Camera: Topcon TRC-50DX; color fundus photograph; mydriatic (tropicamide and phenylephrine); field includes the optic disc and macula: 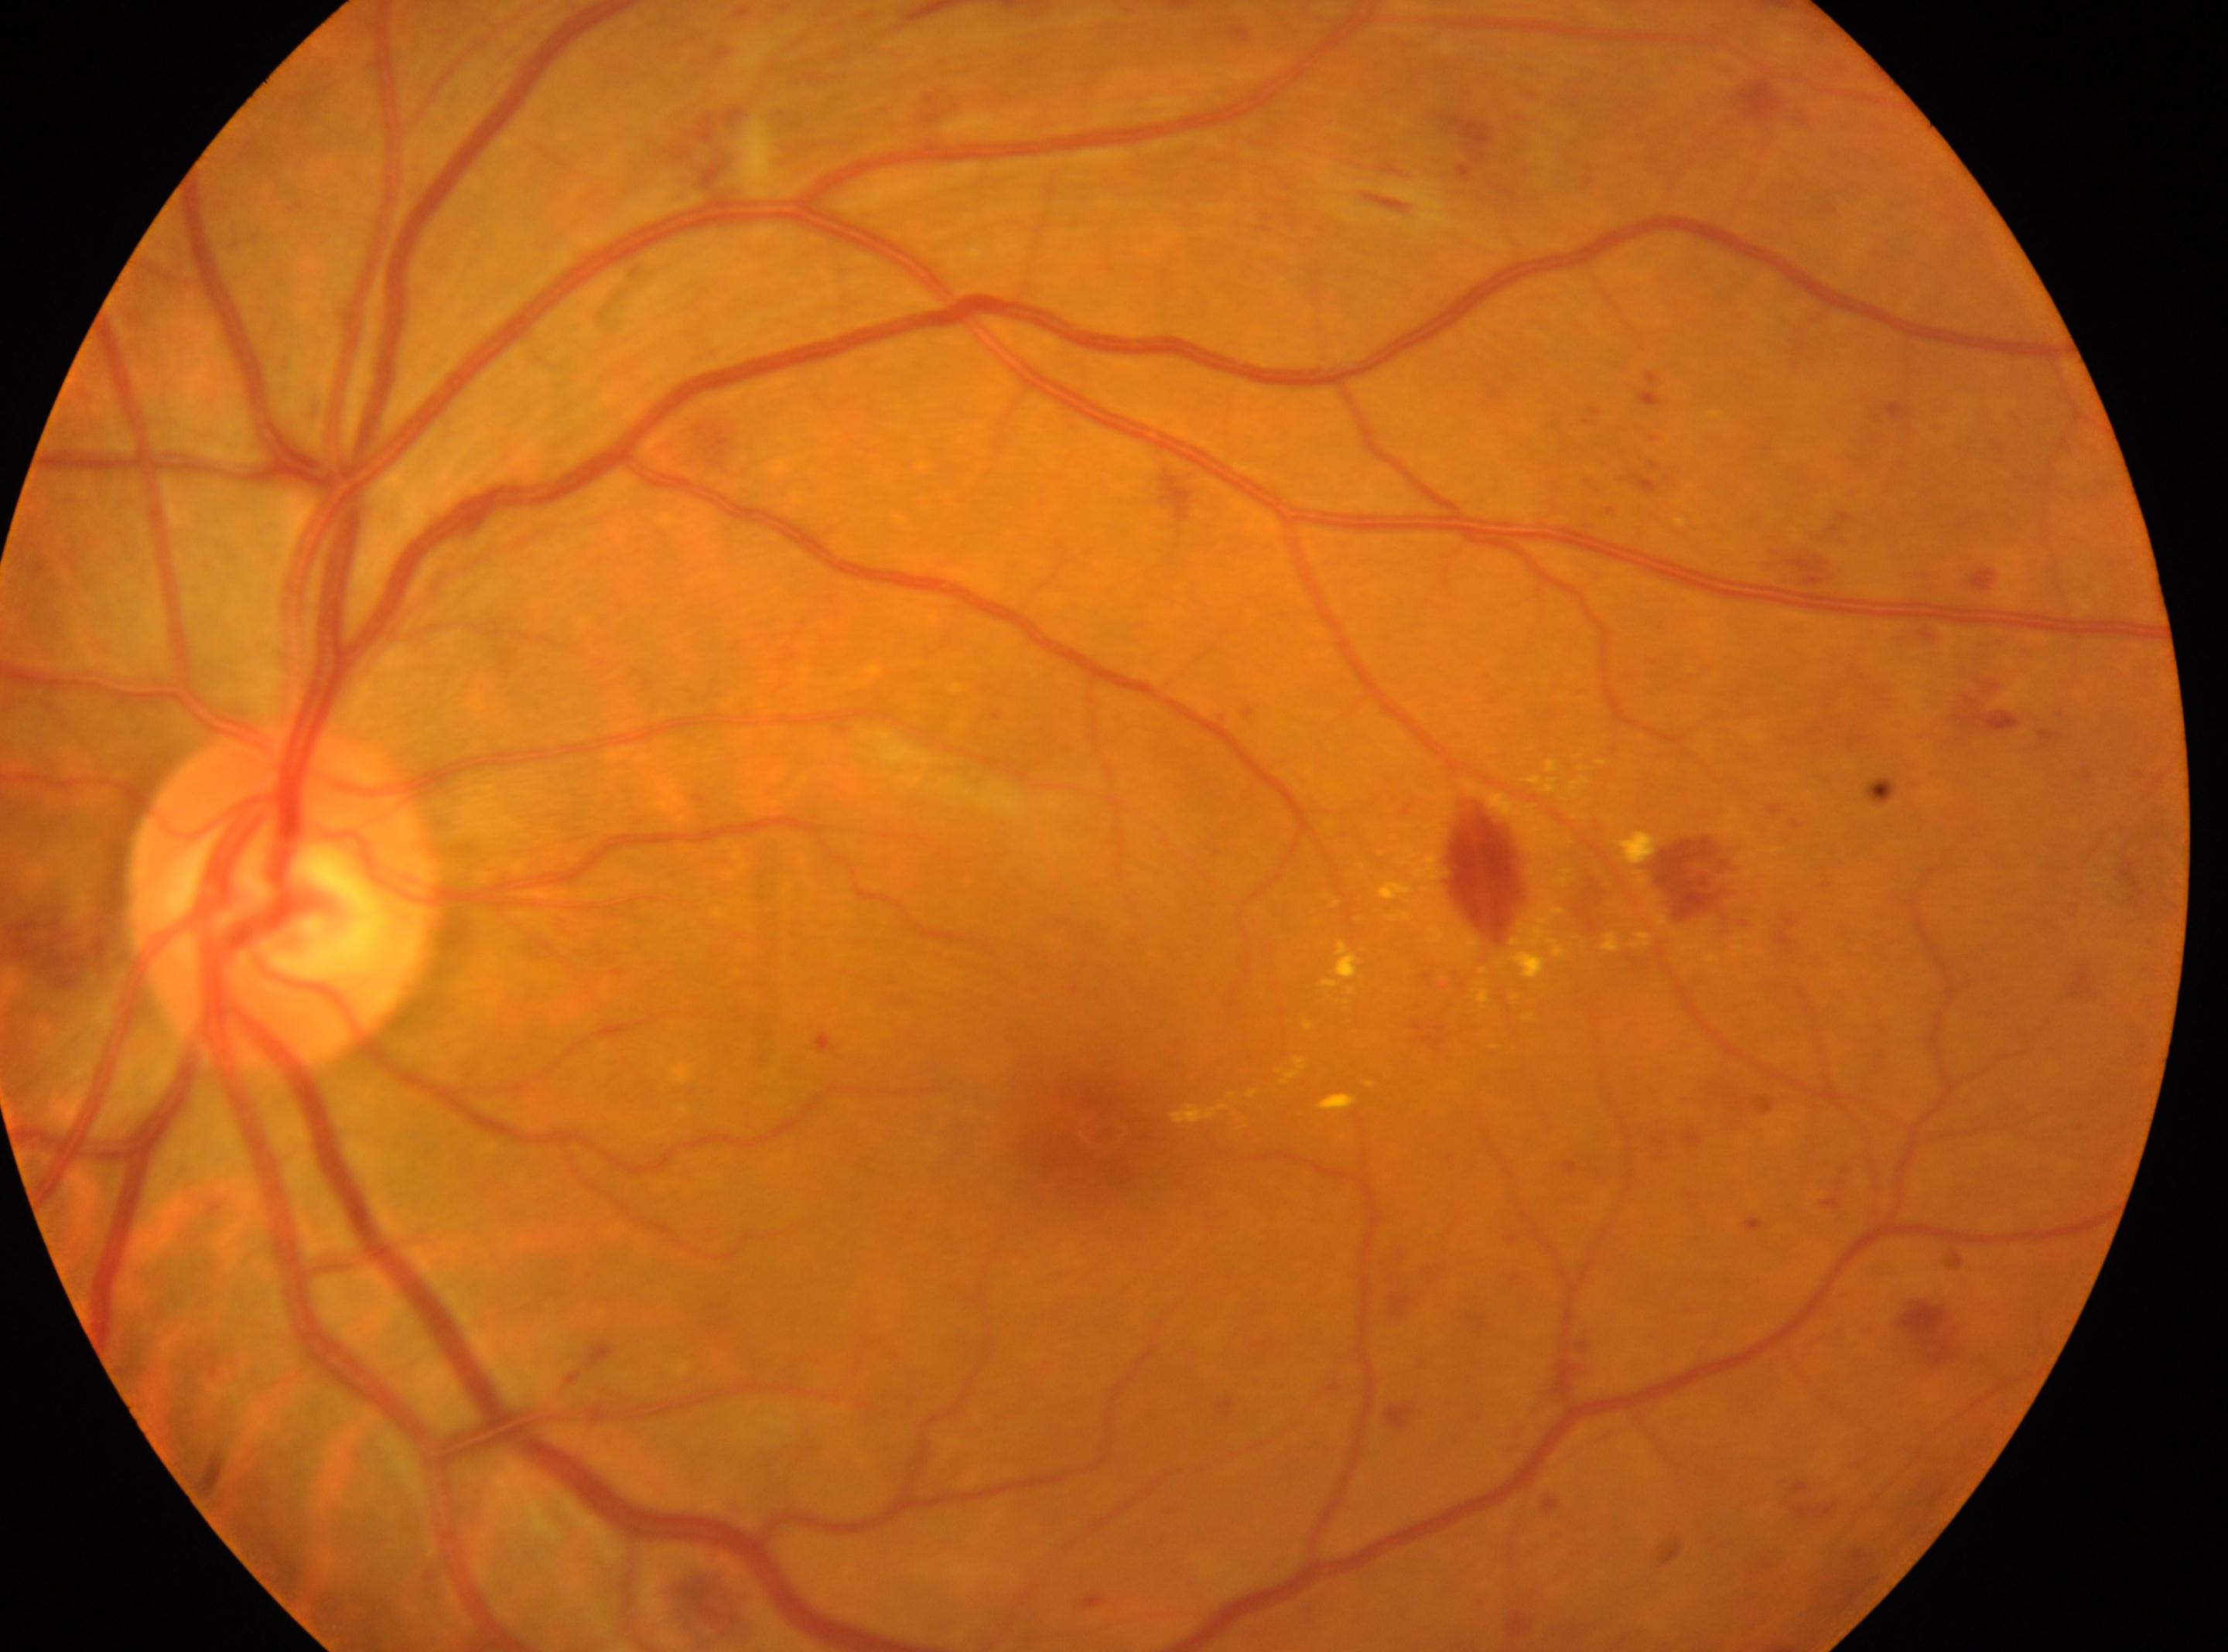 The disc center is at x=283, y=893.
The fovea center is at x=1095, y=1137.
DR severity is 2.
The image shows the left eye.